Captured after pupil dilation: 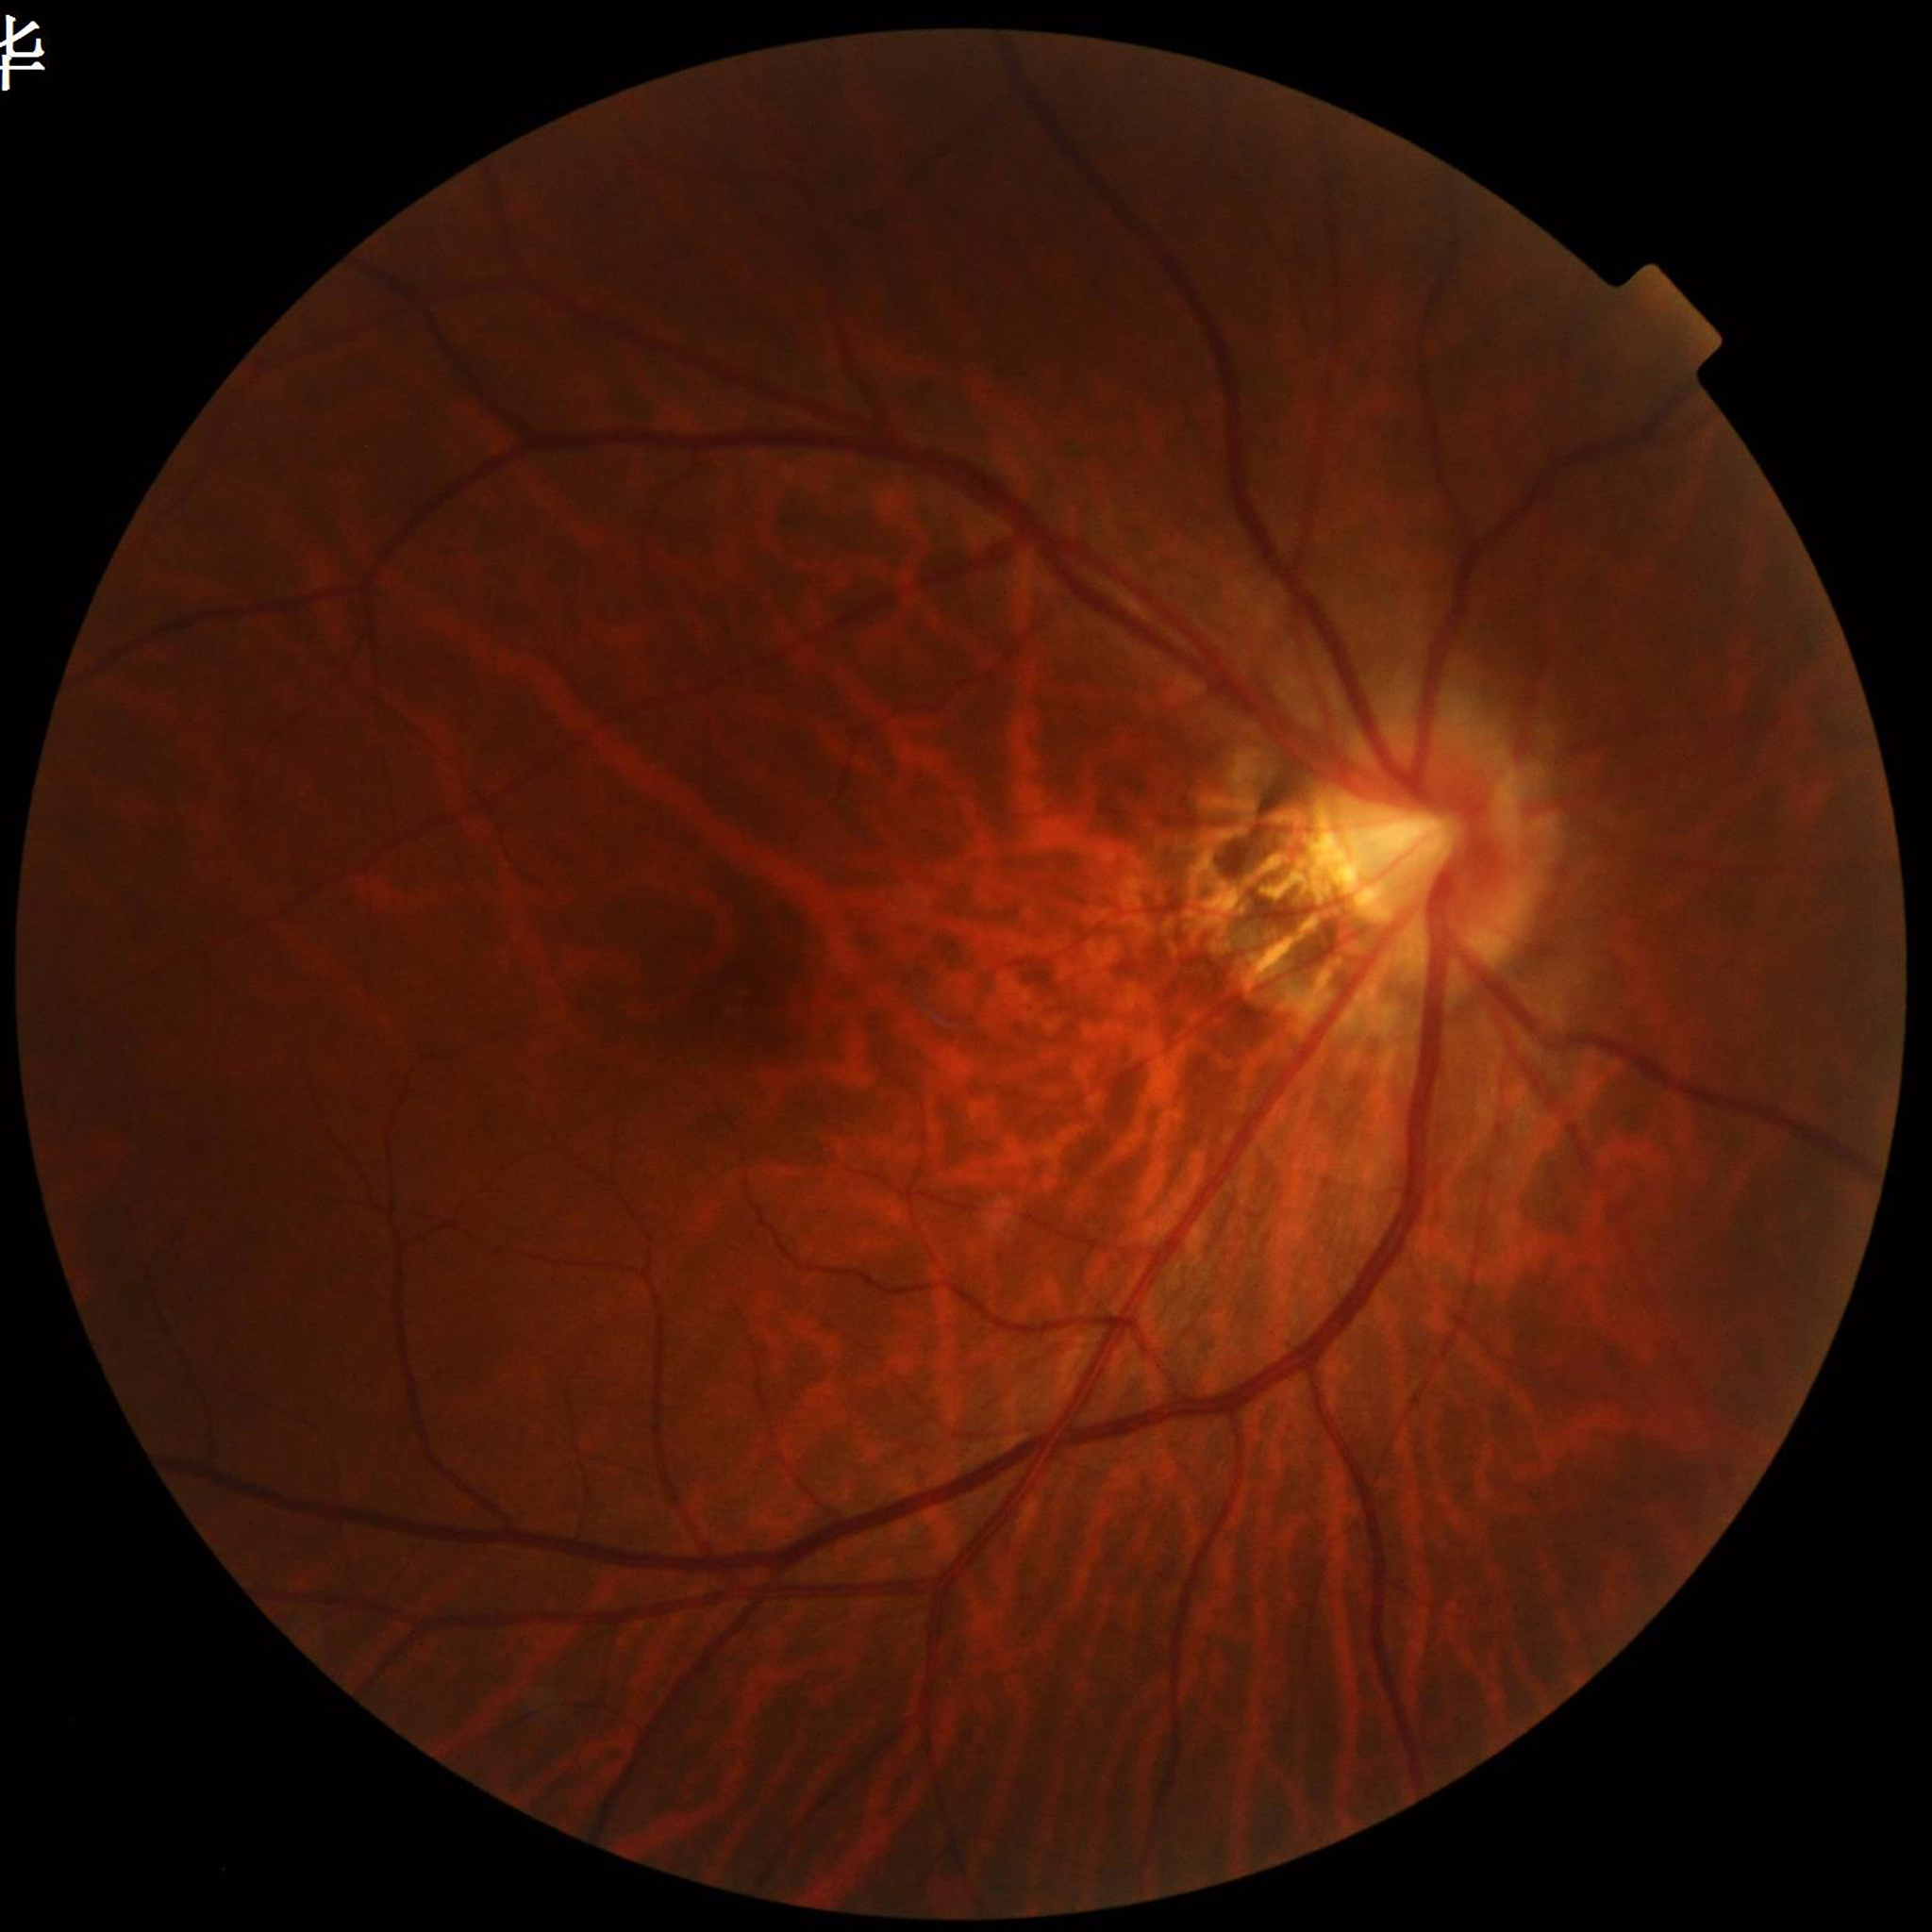
Photo quality: no quality issues identified; Diagnosis: age-related macular degeneration.